Camera: Phoenix ICON (100° FOV); wide-field fundus image from infant ROP screening: 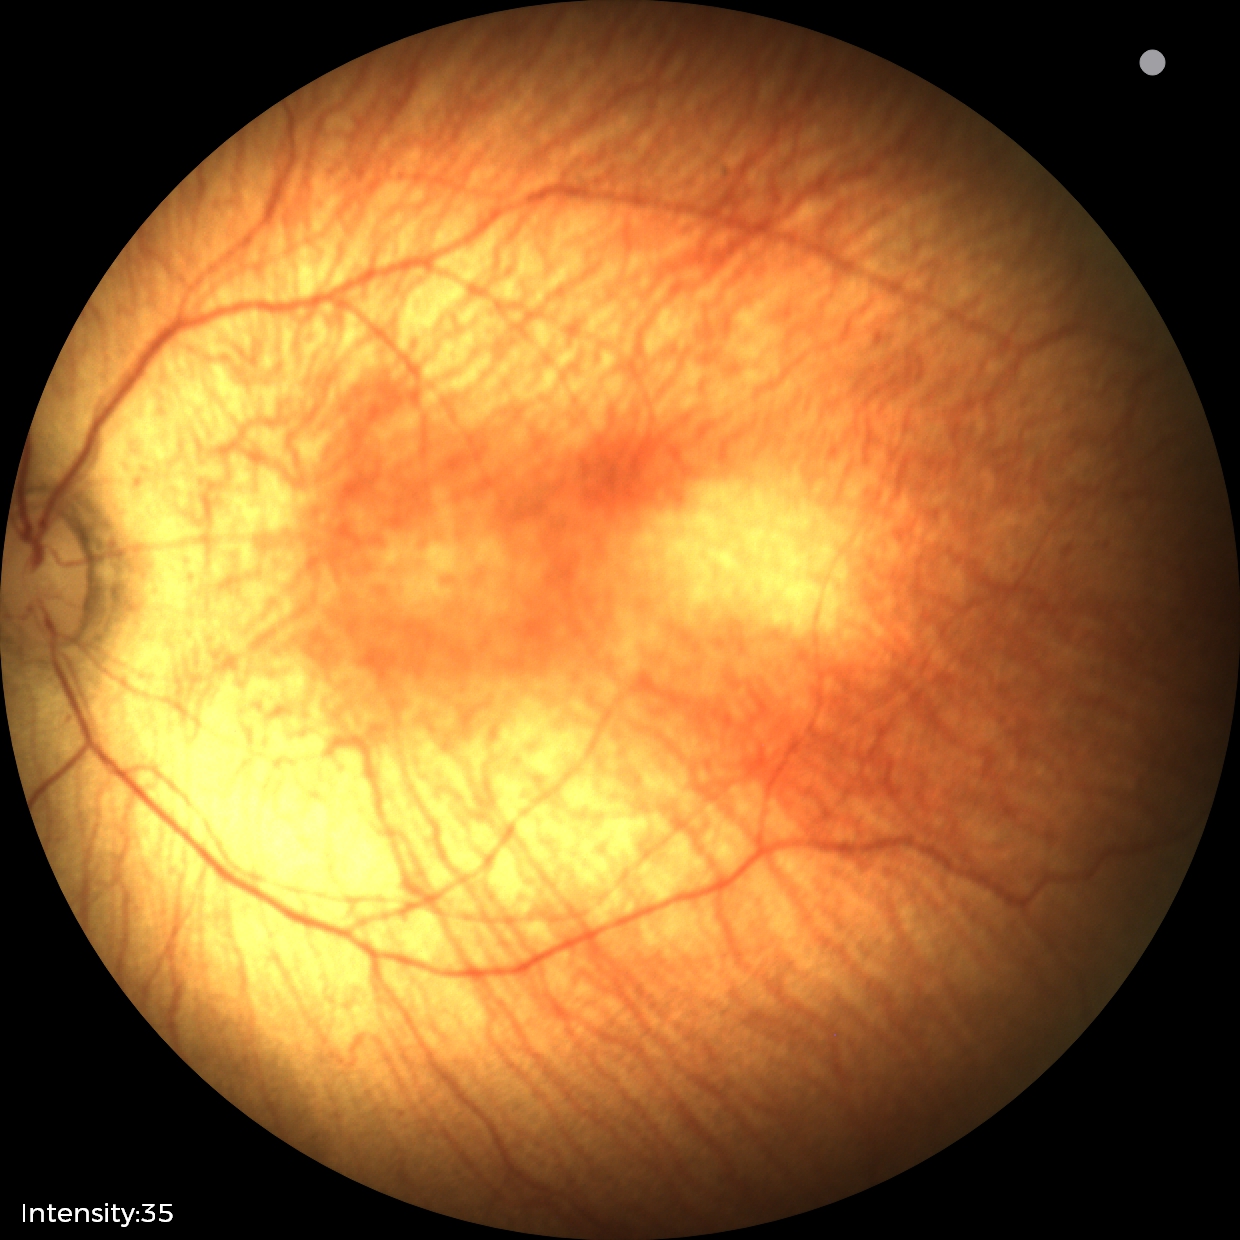

Plus form: absent; finding: status post ROP.